Pediatric wide-field fundus photograph — 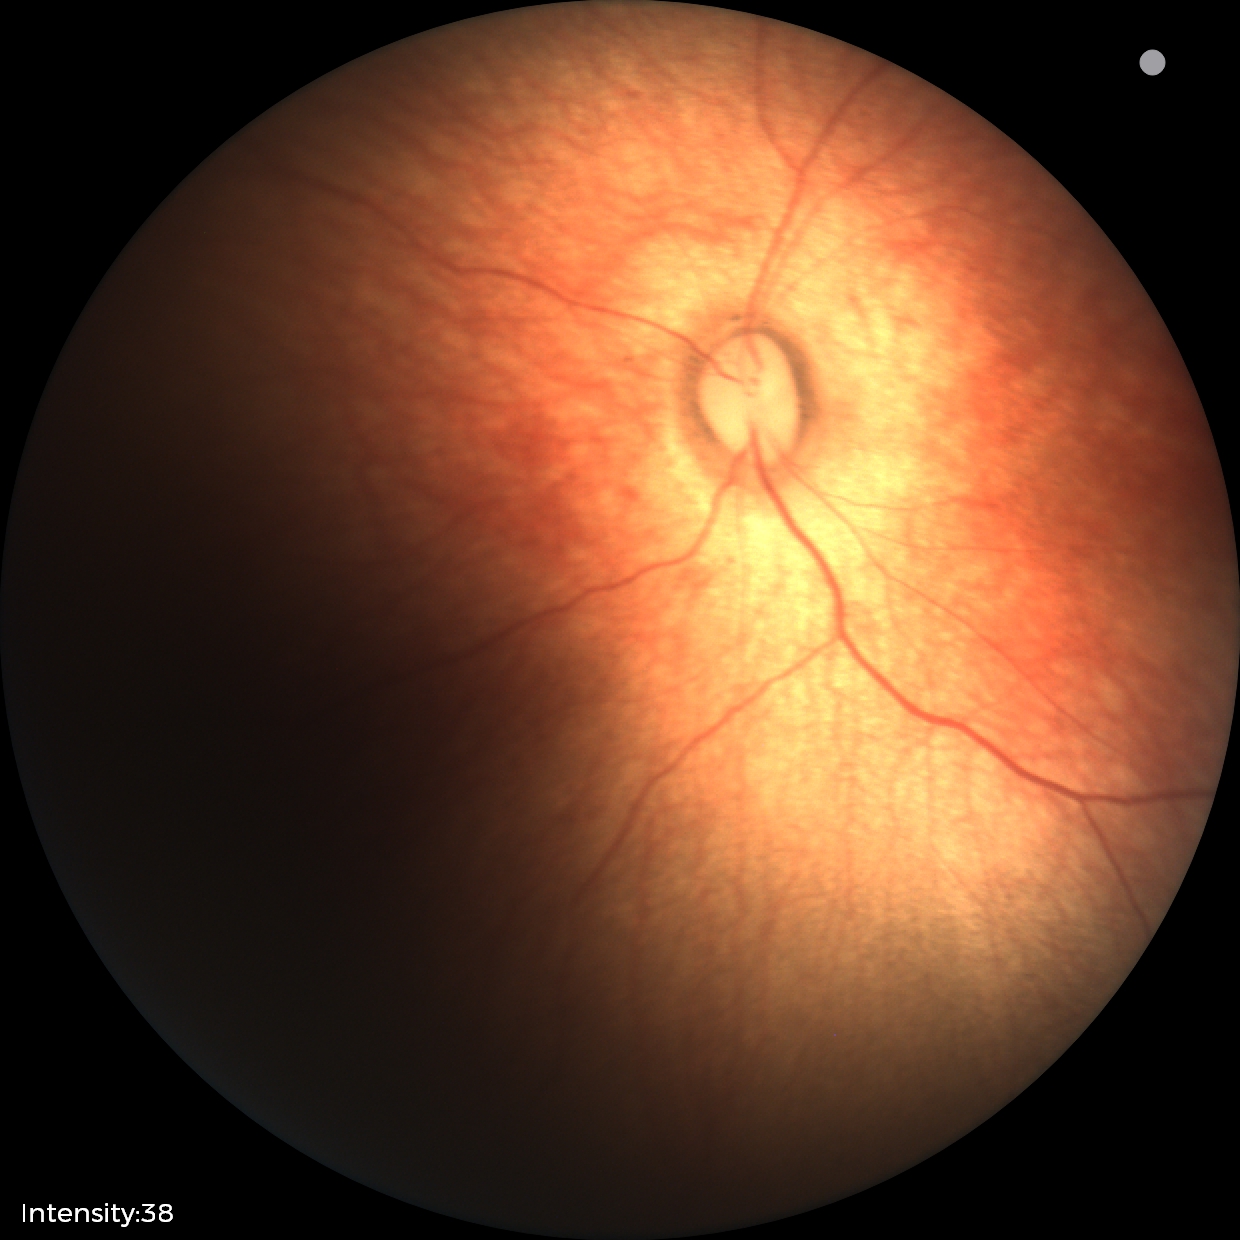

Diagnosis: no abnormalities.